2352 x 1568 pixels.
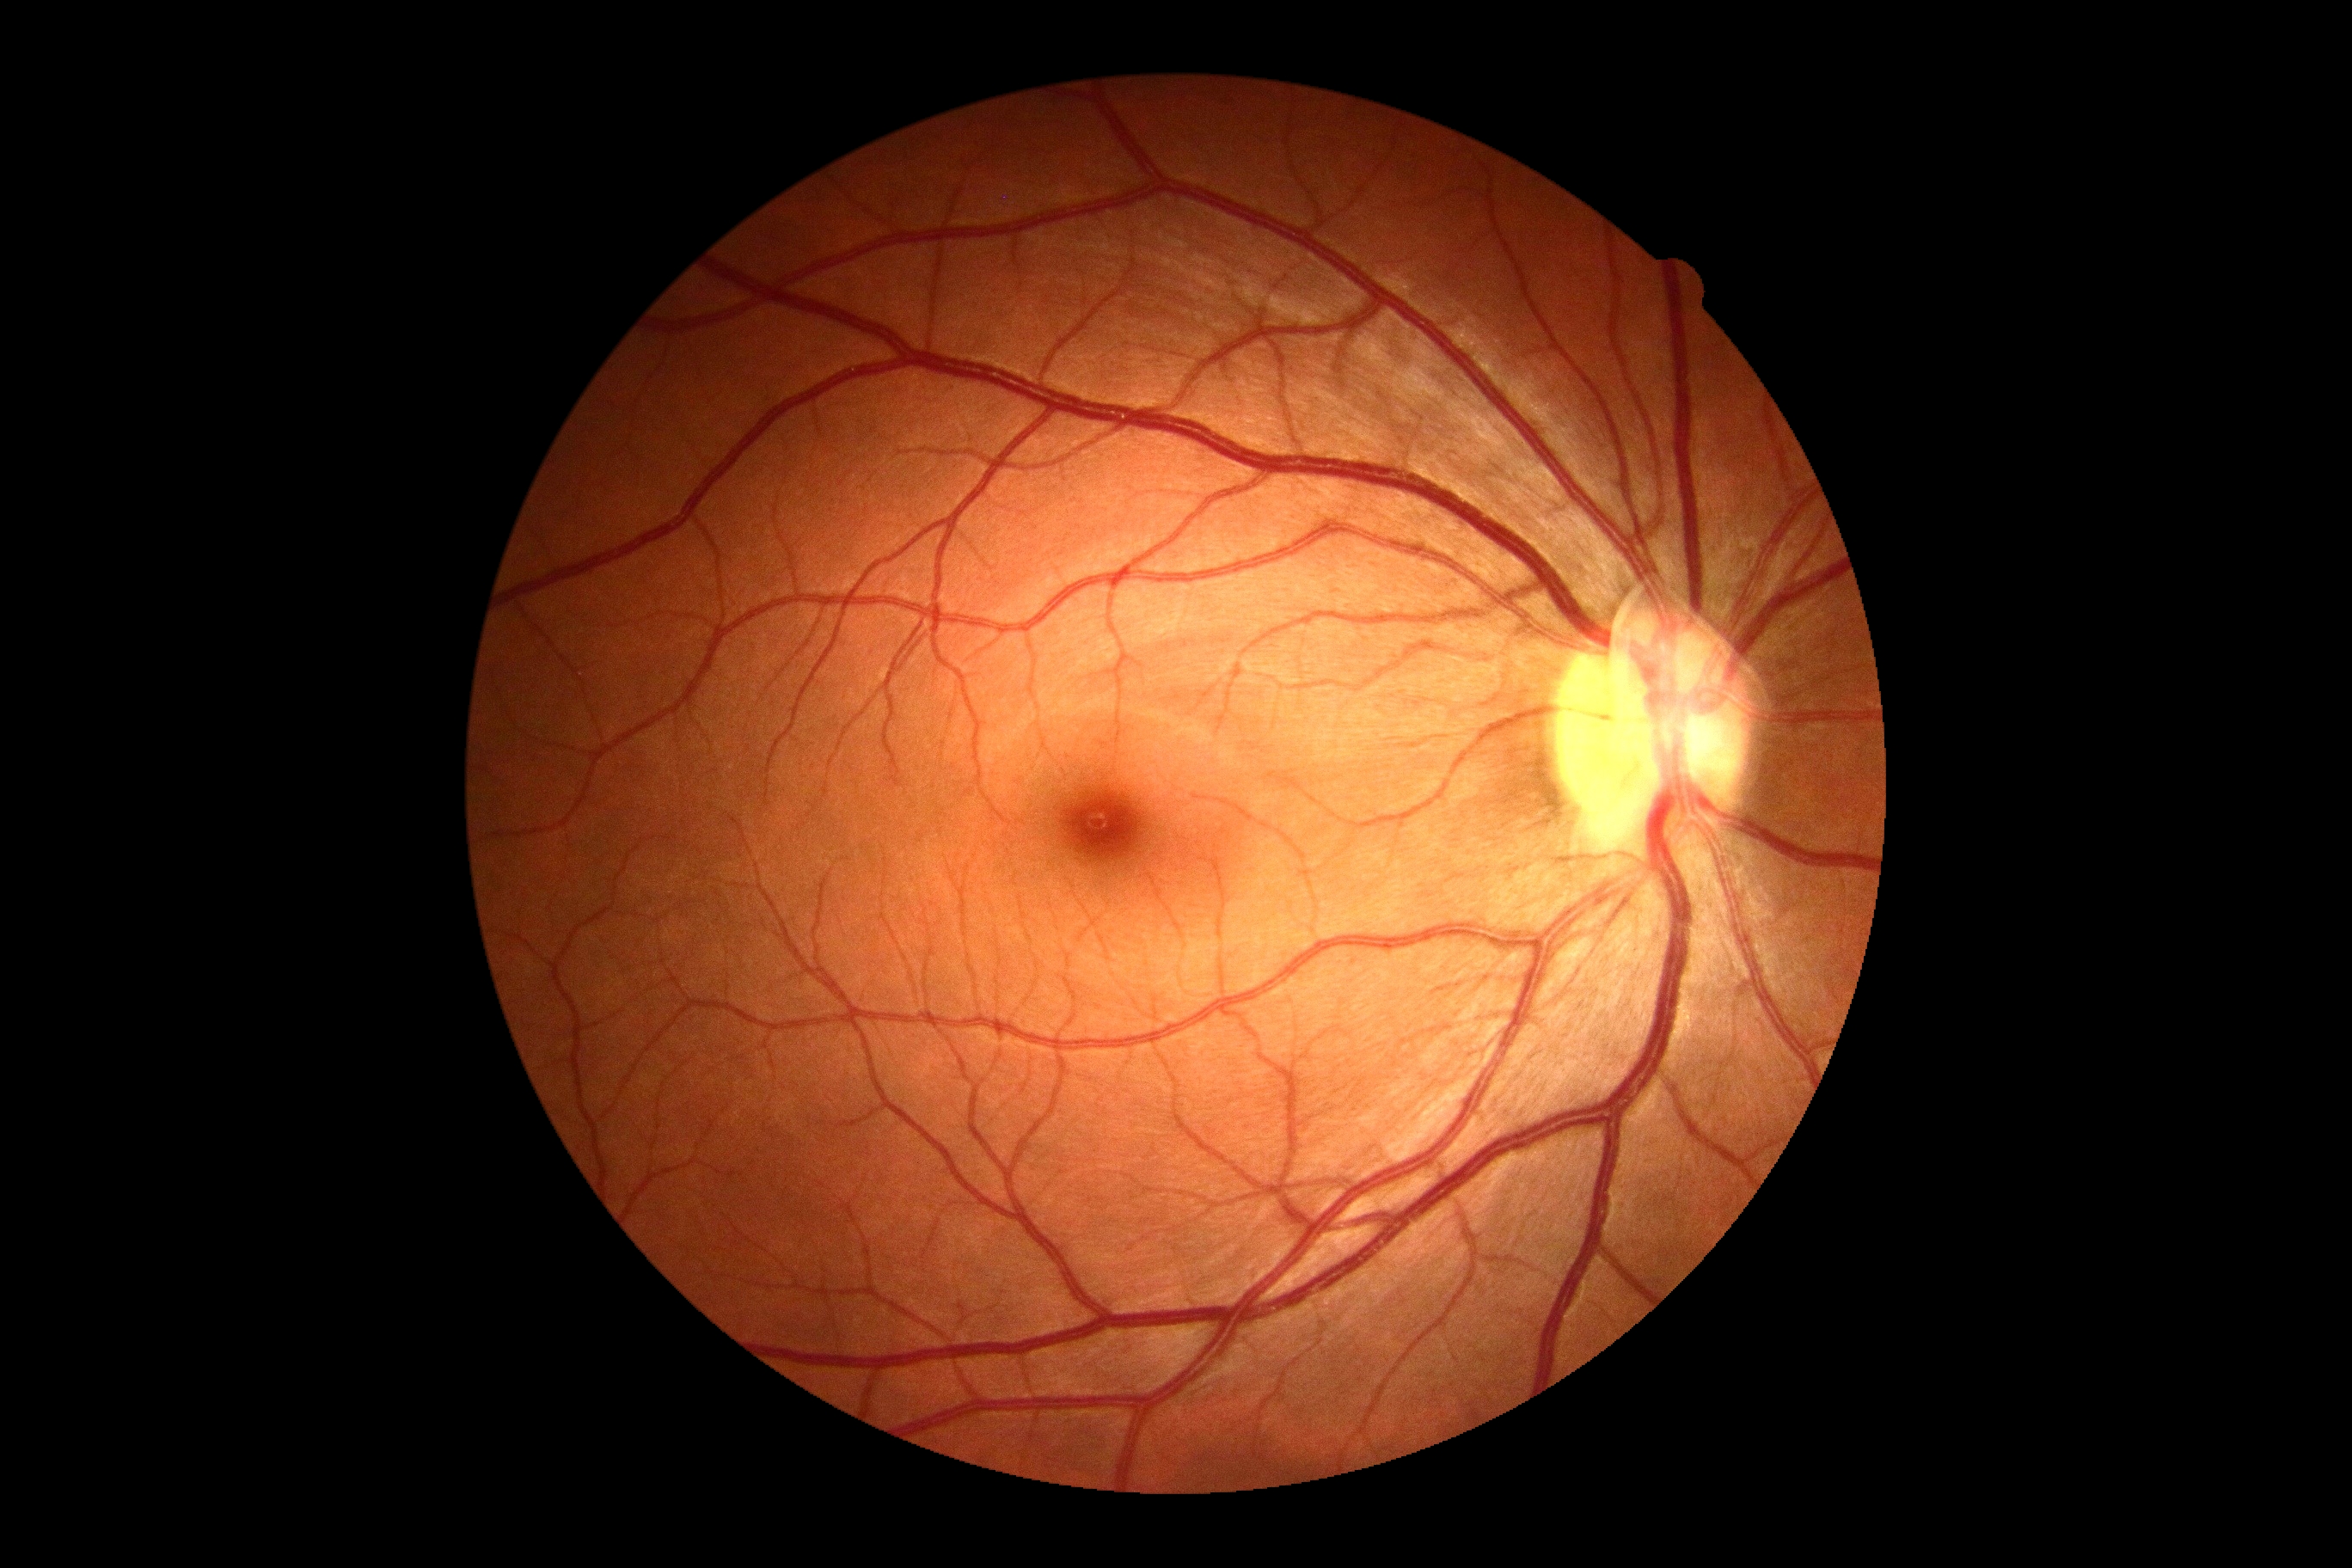
Annotations:
- DR impression — negative for DR
- diabetic retinopathy (DR) — 0/4